Retinal fundus photograph: 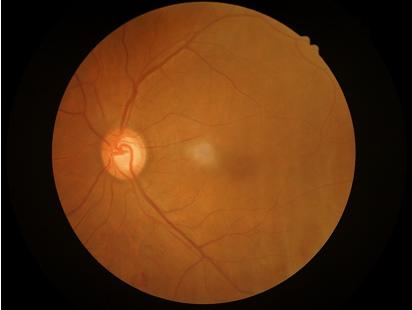

Vessels and details are readily distinguishable.
Optic disc, vessels, and background are in focus.
Overall image quality is good.
No over- or under-exposure.